45° field of view — 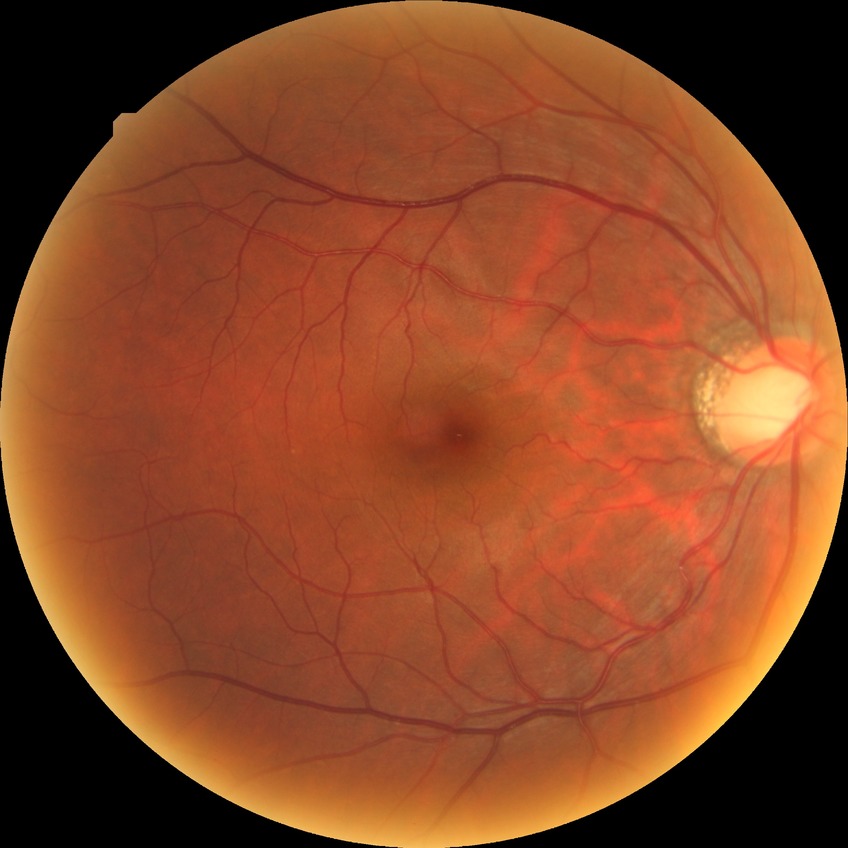
Retinopathy grade: no diabetic retinopathy.